Phoenix ICON, 100° FOV. Infant wide-field retinal image. 1240 by 1240 pixels — 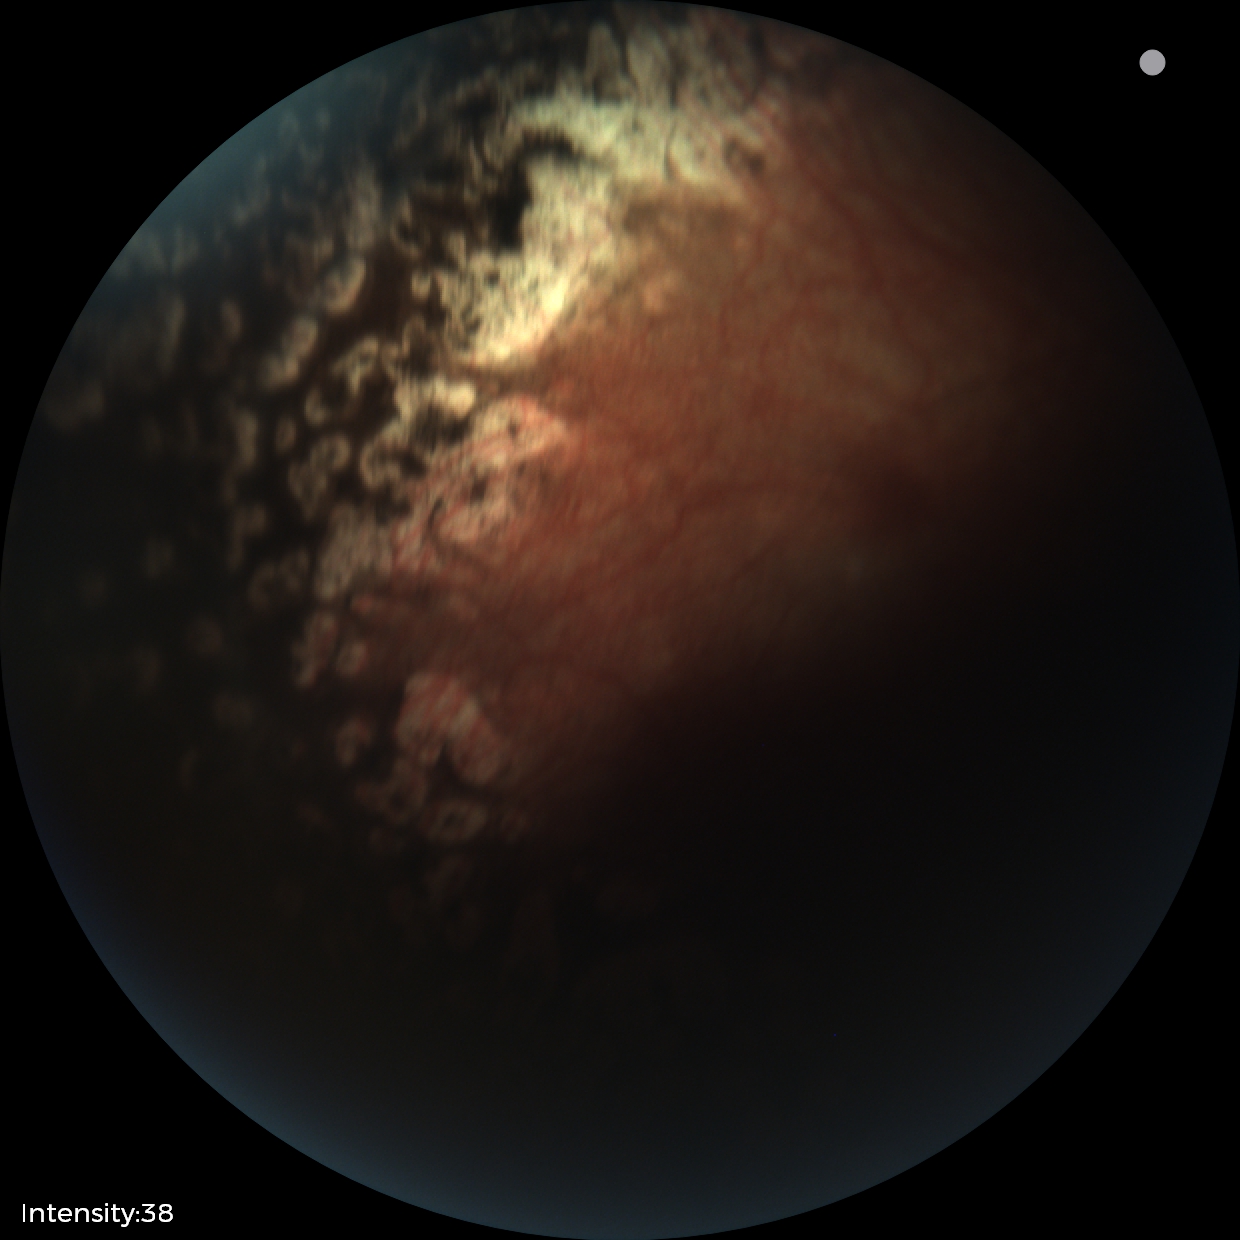 Finding: status post retinopathy of prematurity — retinal appearance after treated retinopathy of prematurity; plus form: absent — posterior pole vessels without abnormal dilation or tortuosity.